Wide-field fundus photograph from neonatal ROP screening.
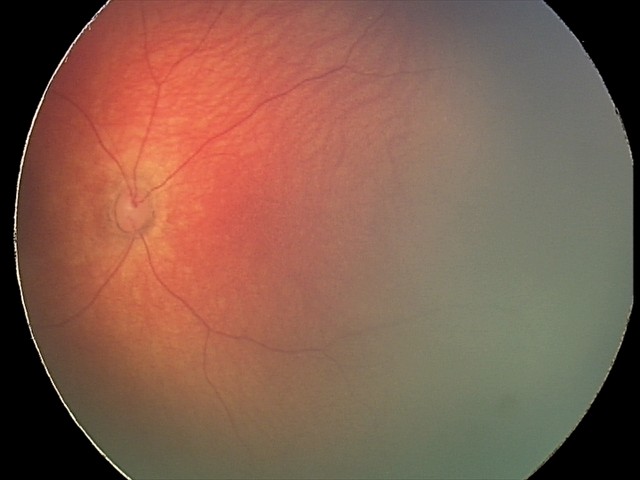

Examination diagnosed as retinal hemorrhages.